2352 by 1568 pixels; color fundus image:
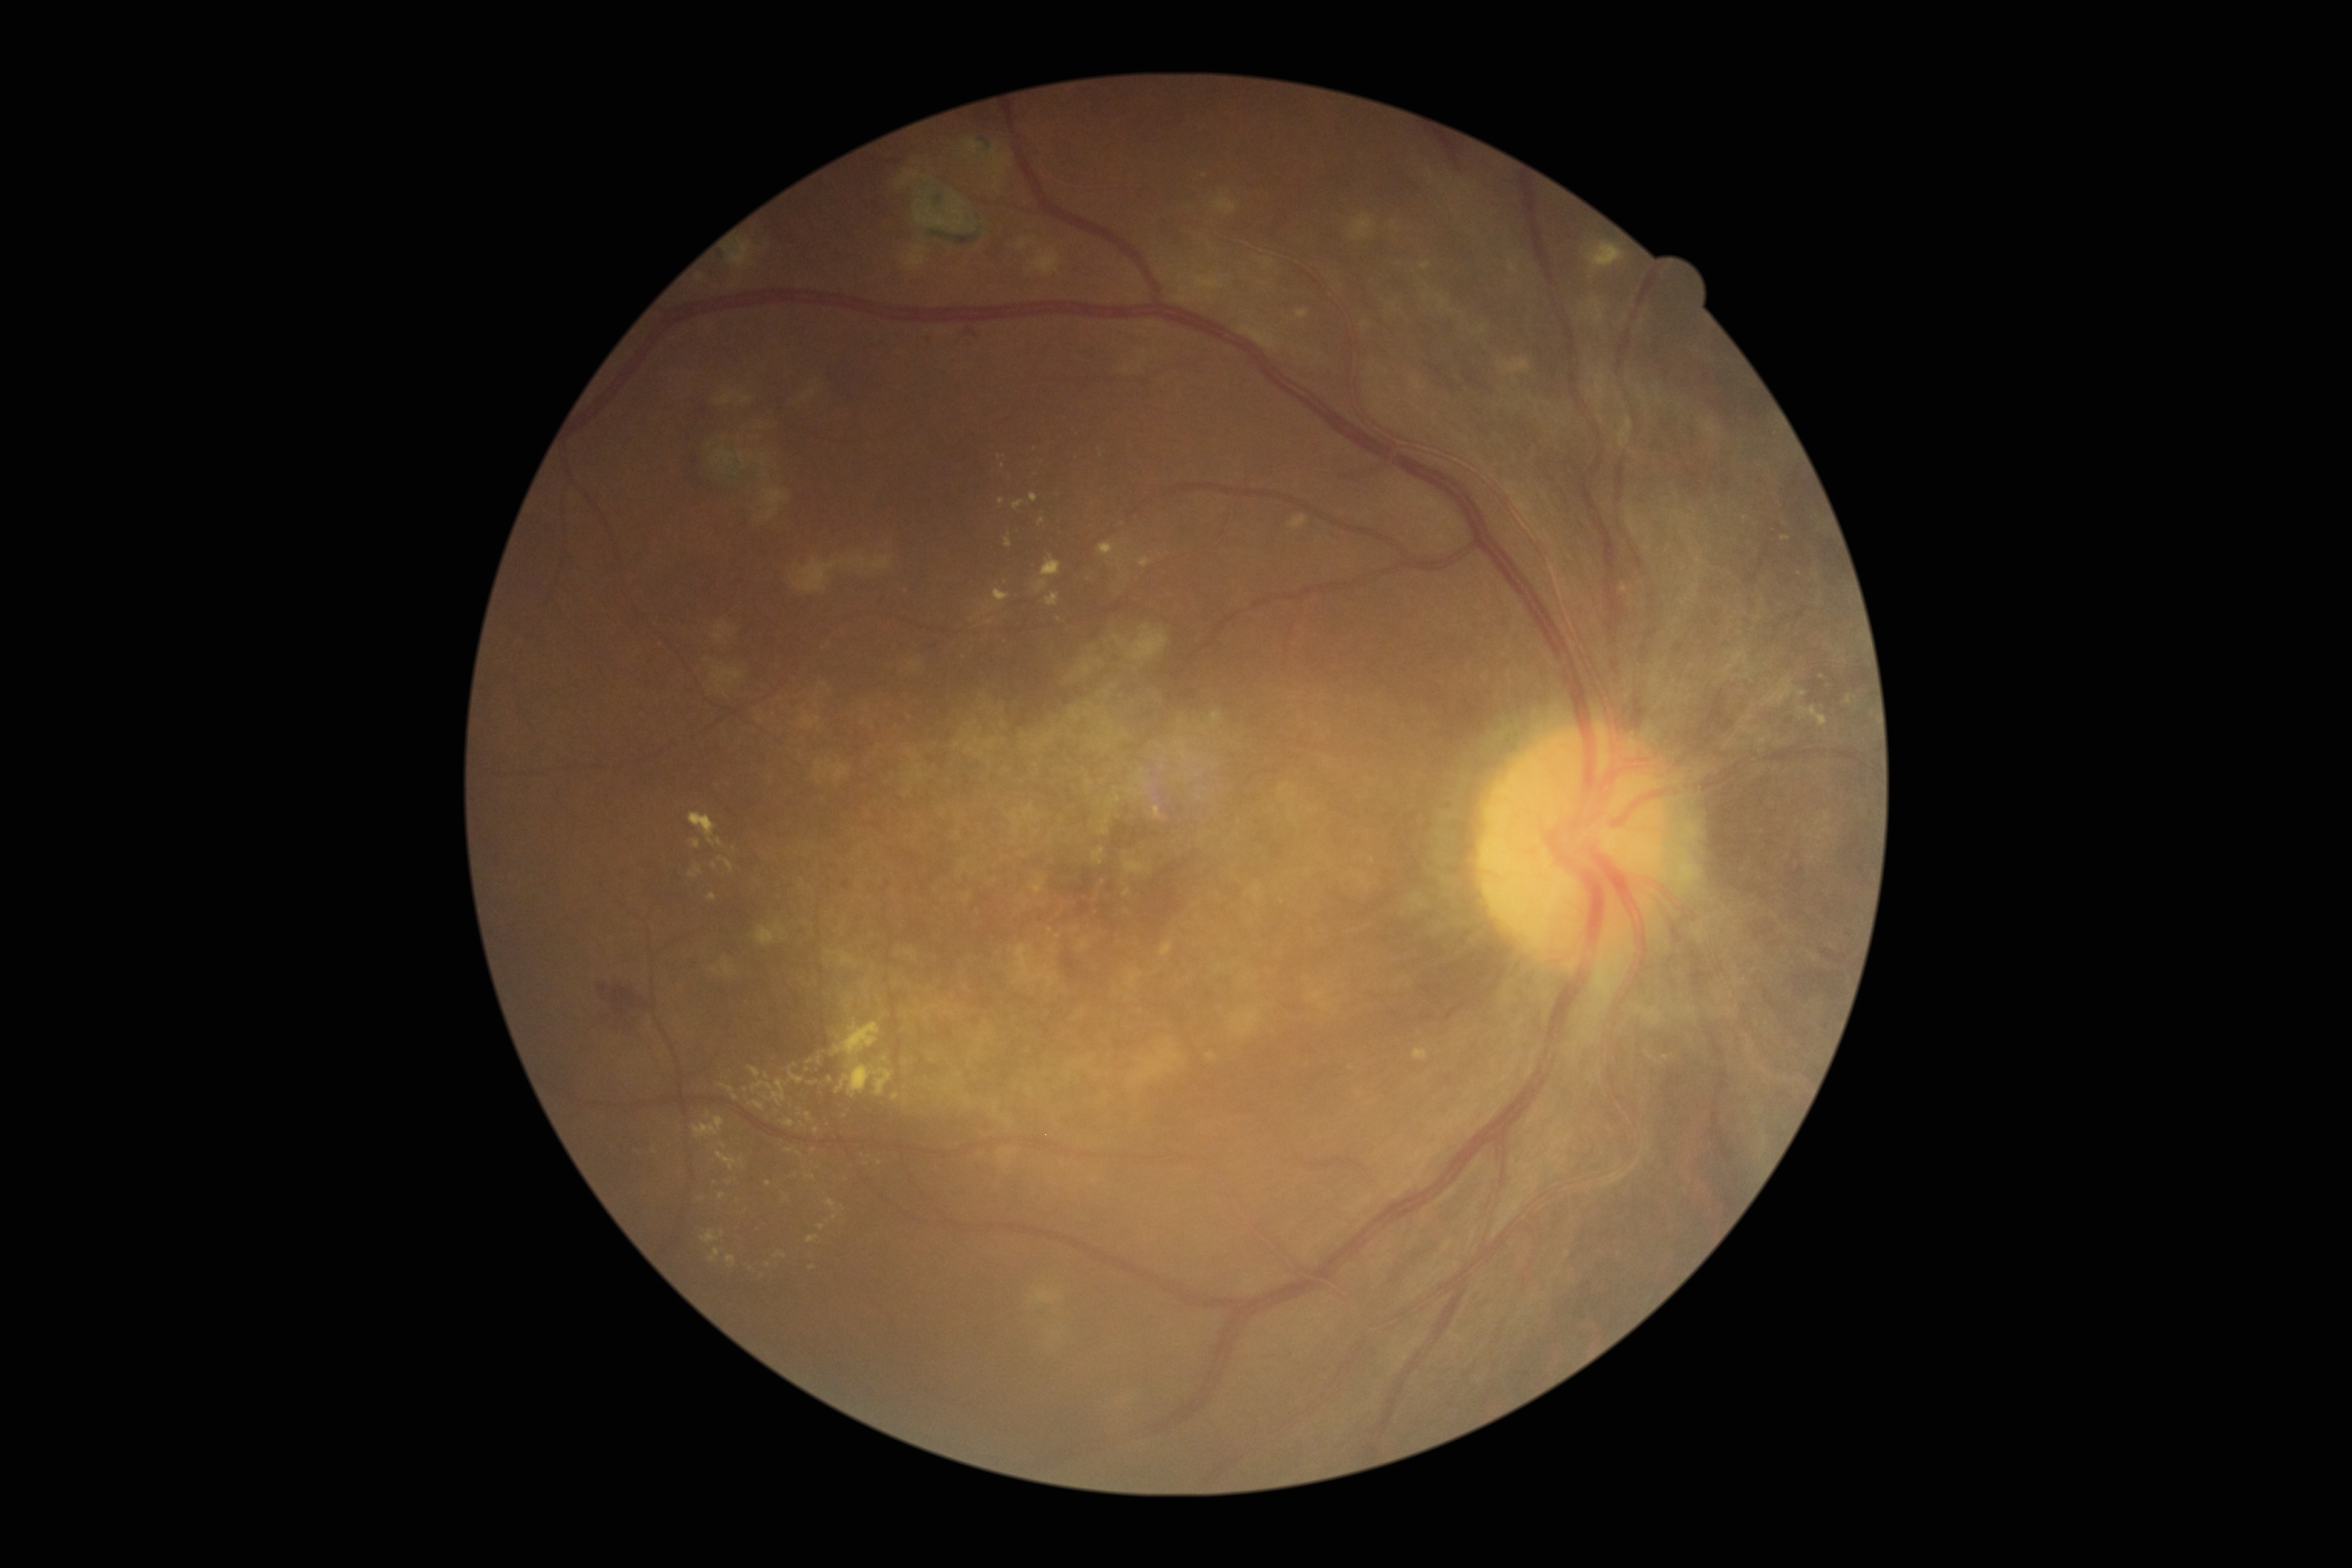
DR stage=grade 4.